Camera: NIDEK AFC-230.
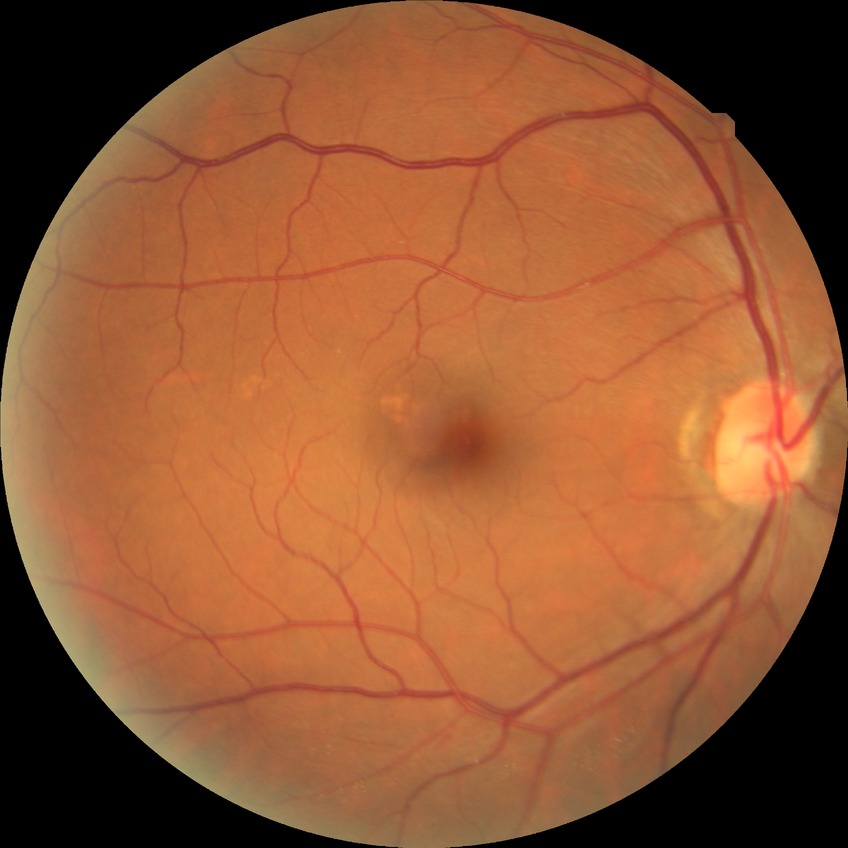

Annotations:
• diabetic retinopathy (DR) — NDR (no diabetic retinopathy)